1240x1240; wide-field fundus photograph of an infant; Phoenix ICON, 100° FOV
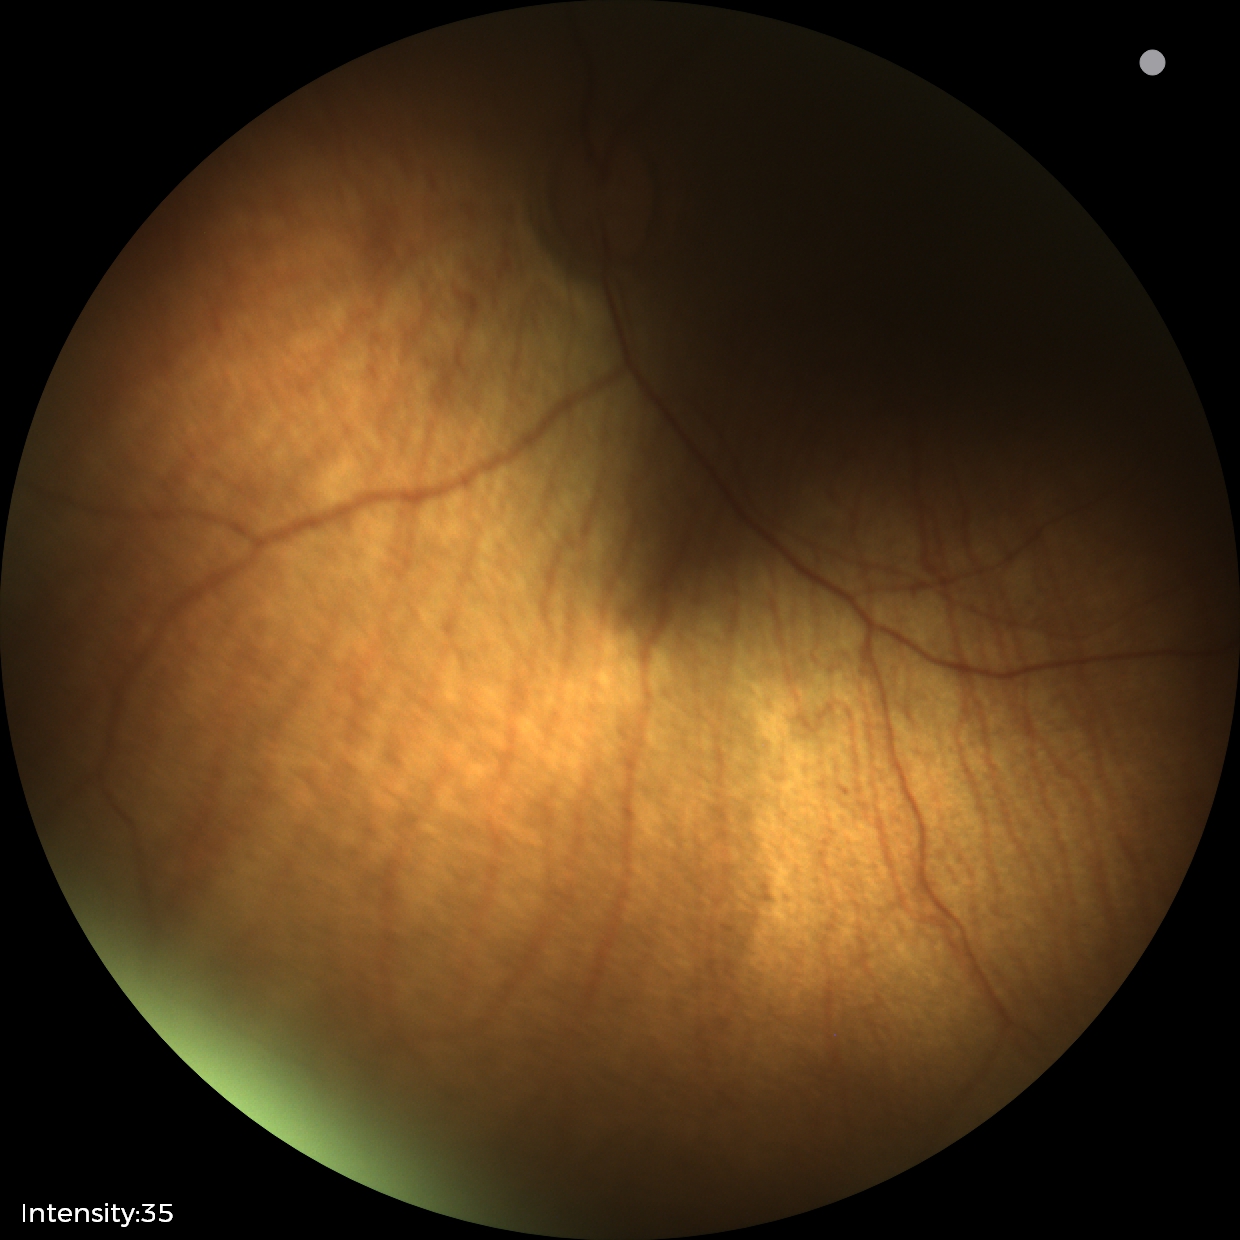
Diagnosis from this screening exam: status post ROP.